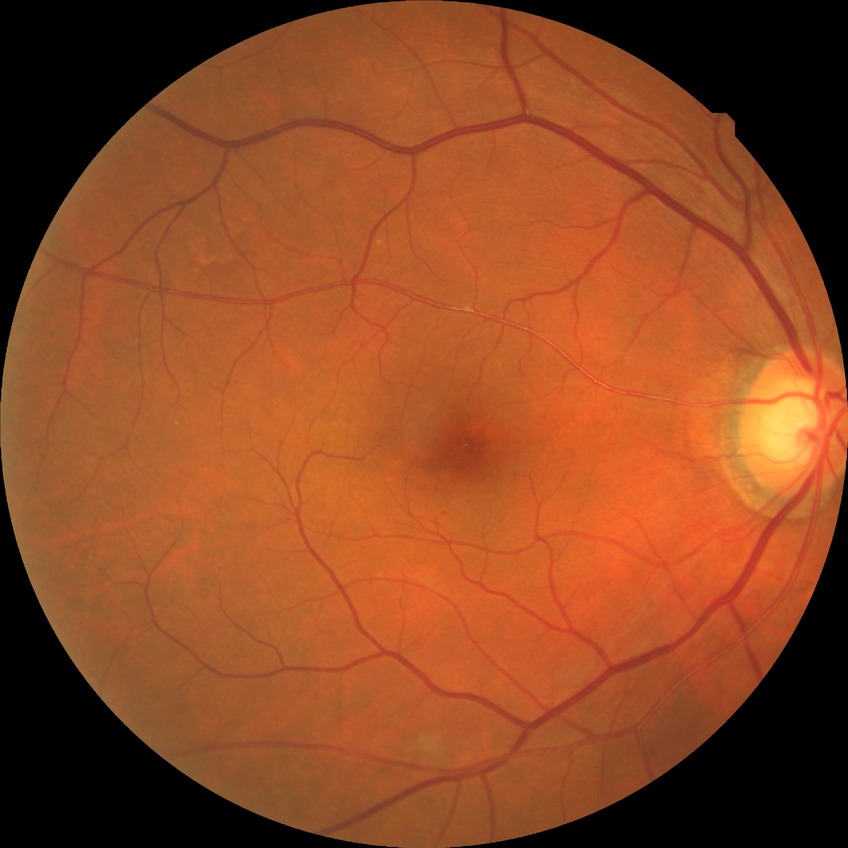 Diabetic retinopathy stage is no diabetic retinopathy.